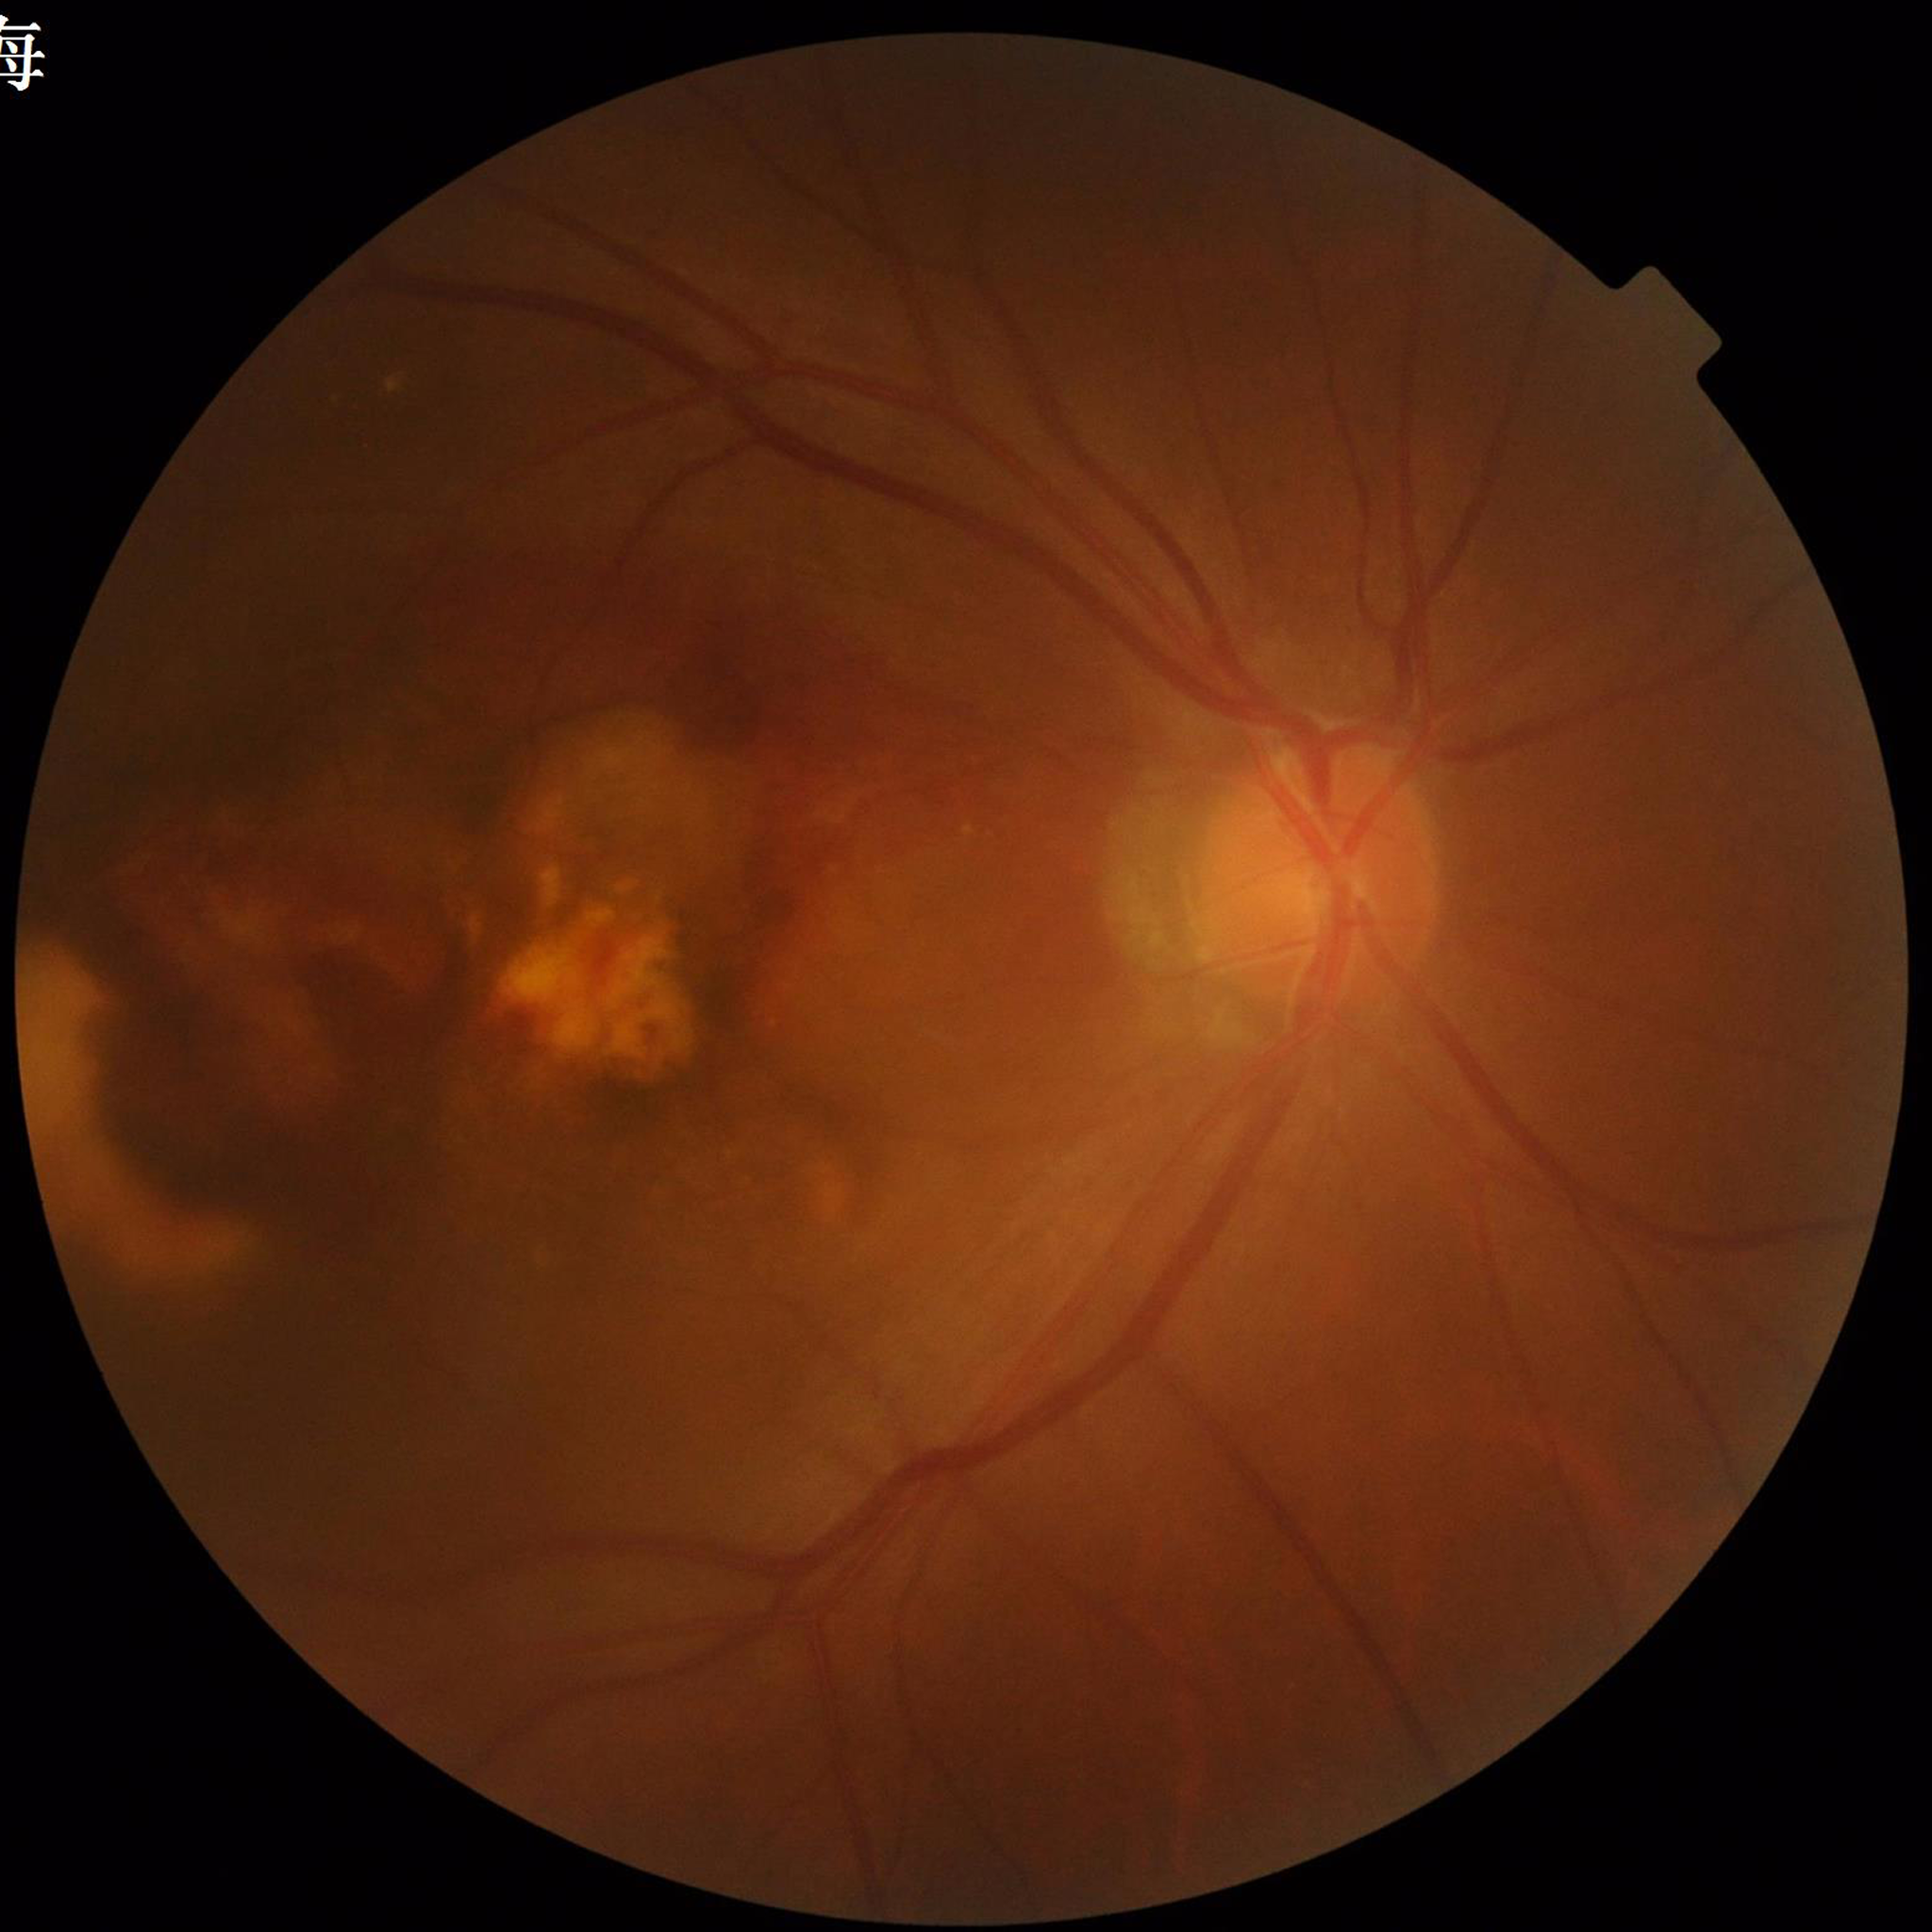

Color fundus photo. Patient diagnosed with AMD.